Disc-centered fundus crop:
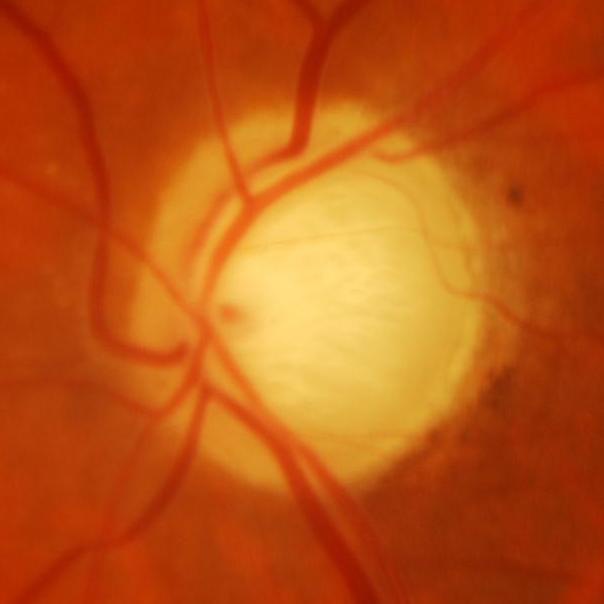 Glaucoma is present. There is evidence of glaucomatous damage to the optic nerve.